CFP · modified Davis grading — 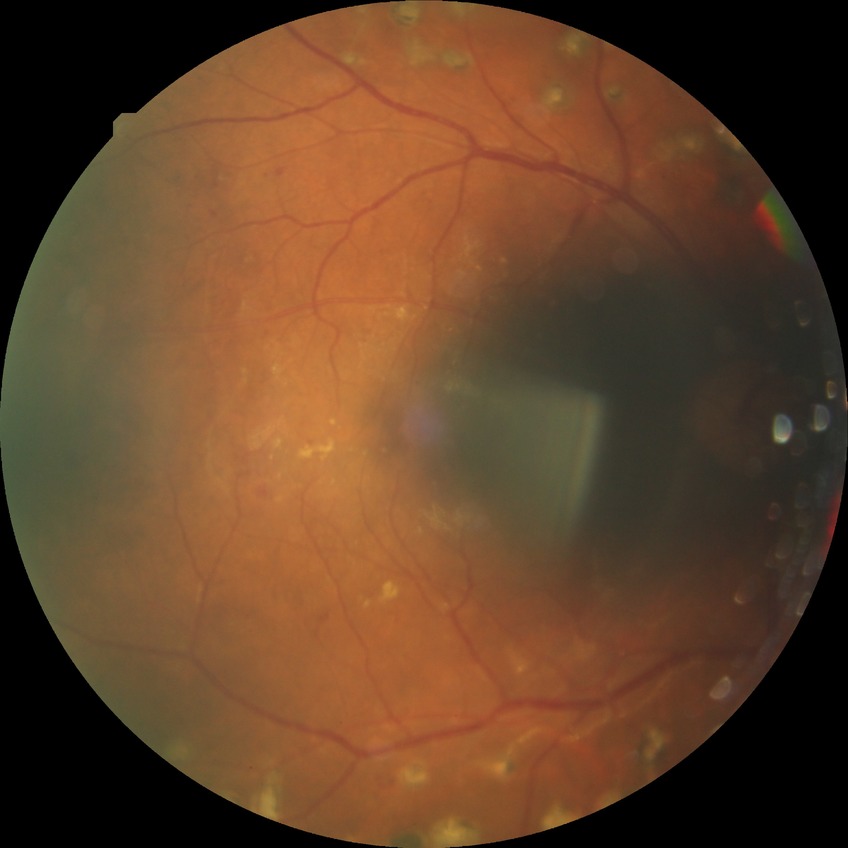 Davis grade is PDR.